Davis DR grading, posterior pole color fundus photograph, FOV: 45 degrees — 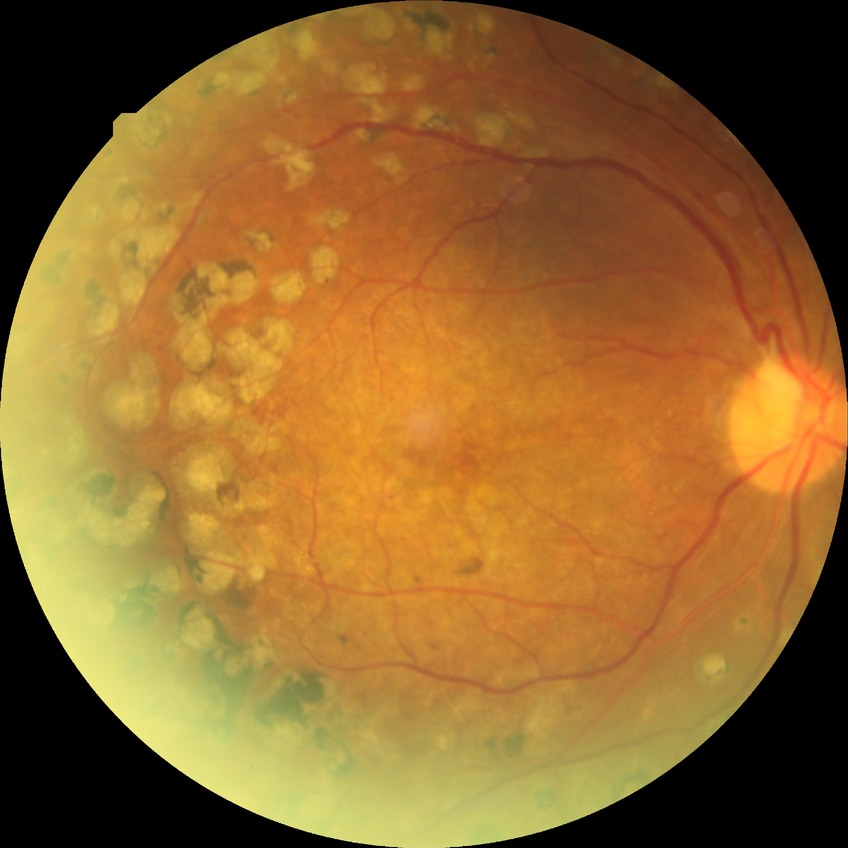 Findings:
- Davis stage — PDR